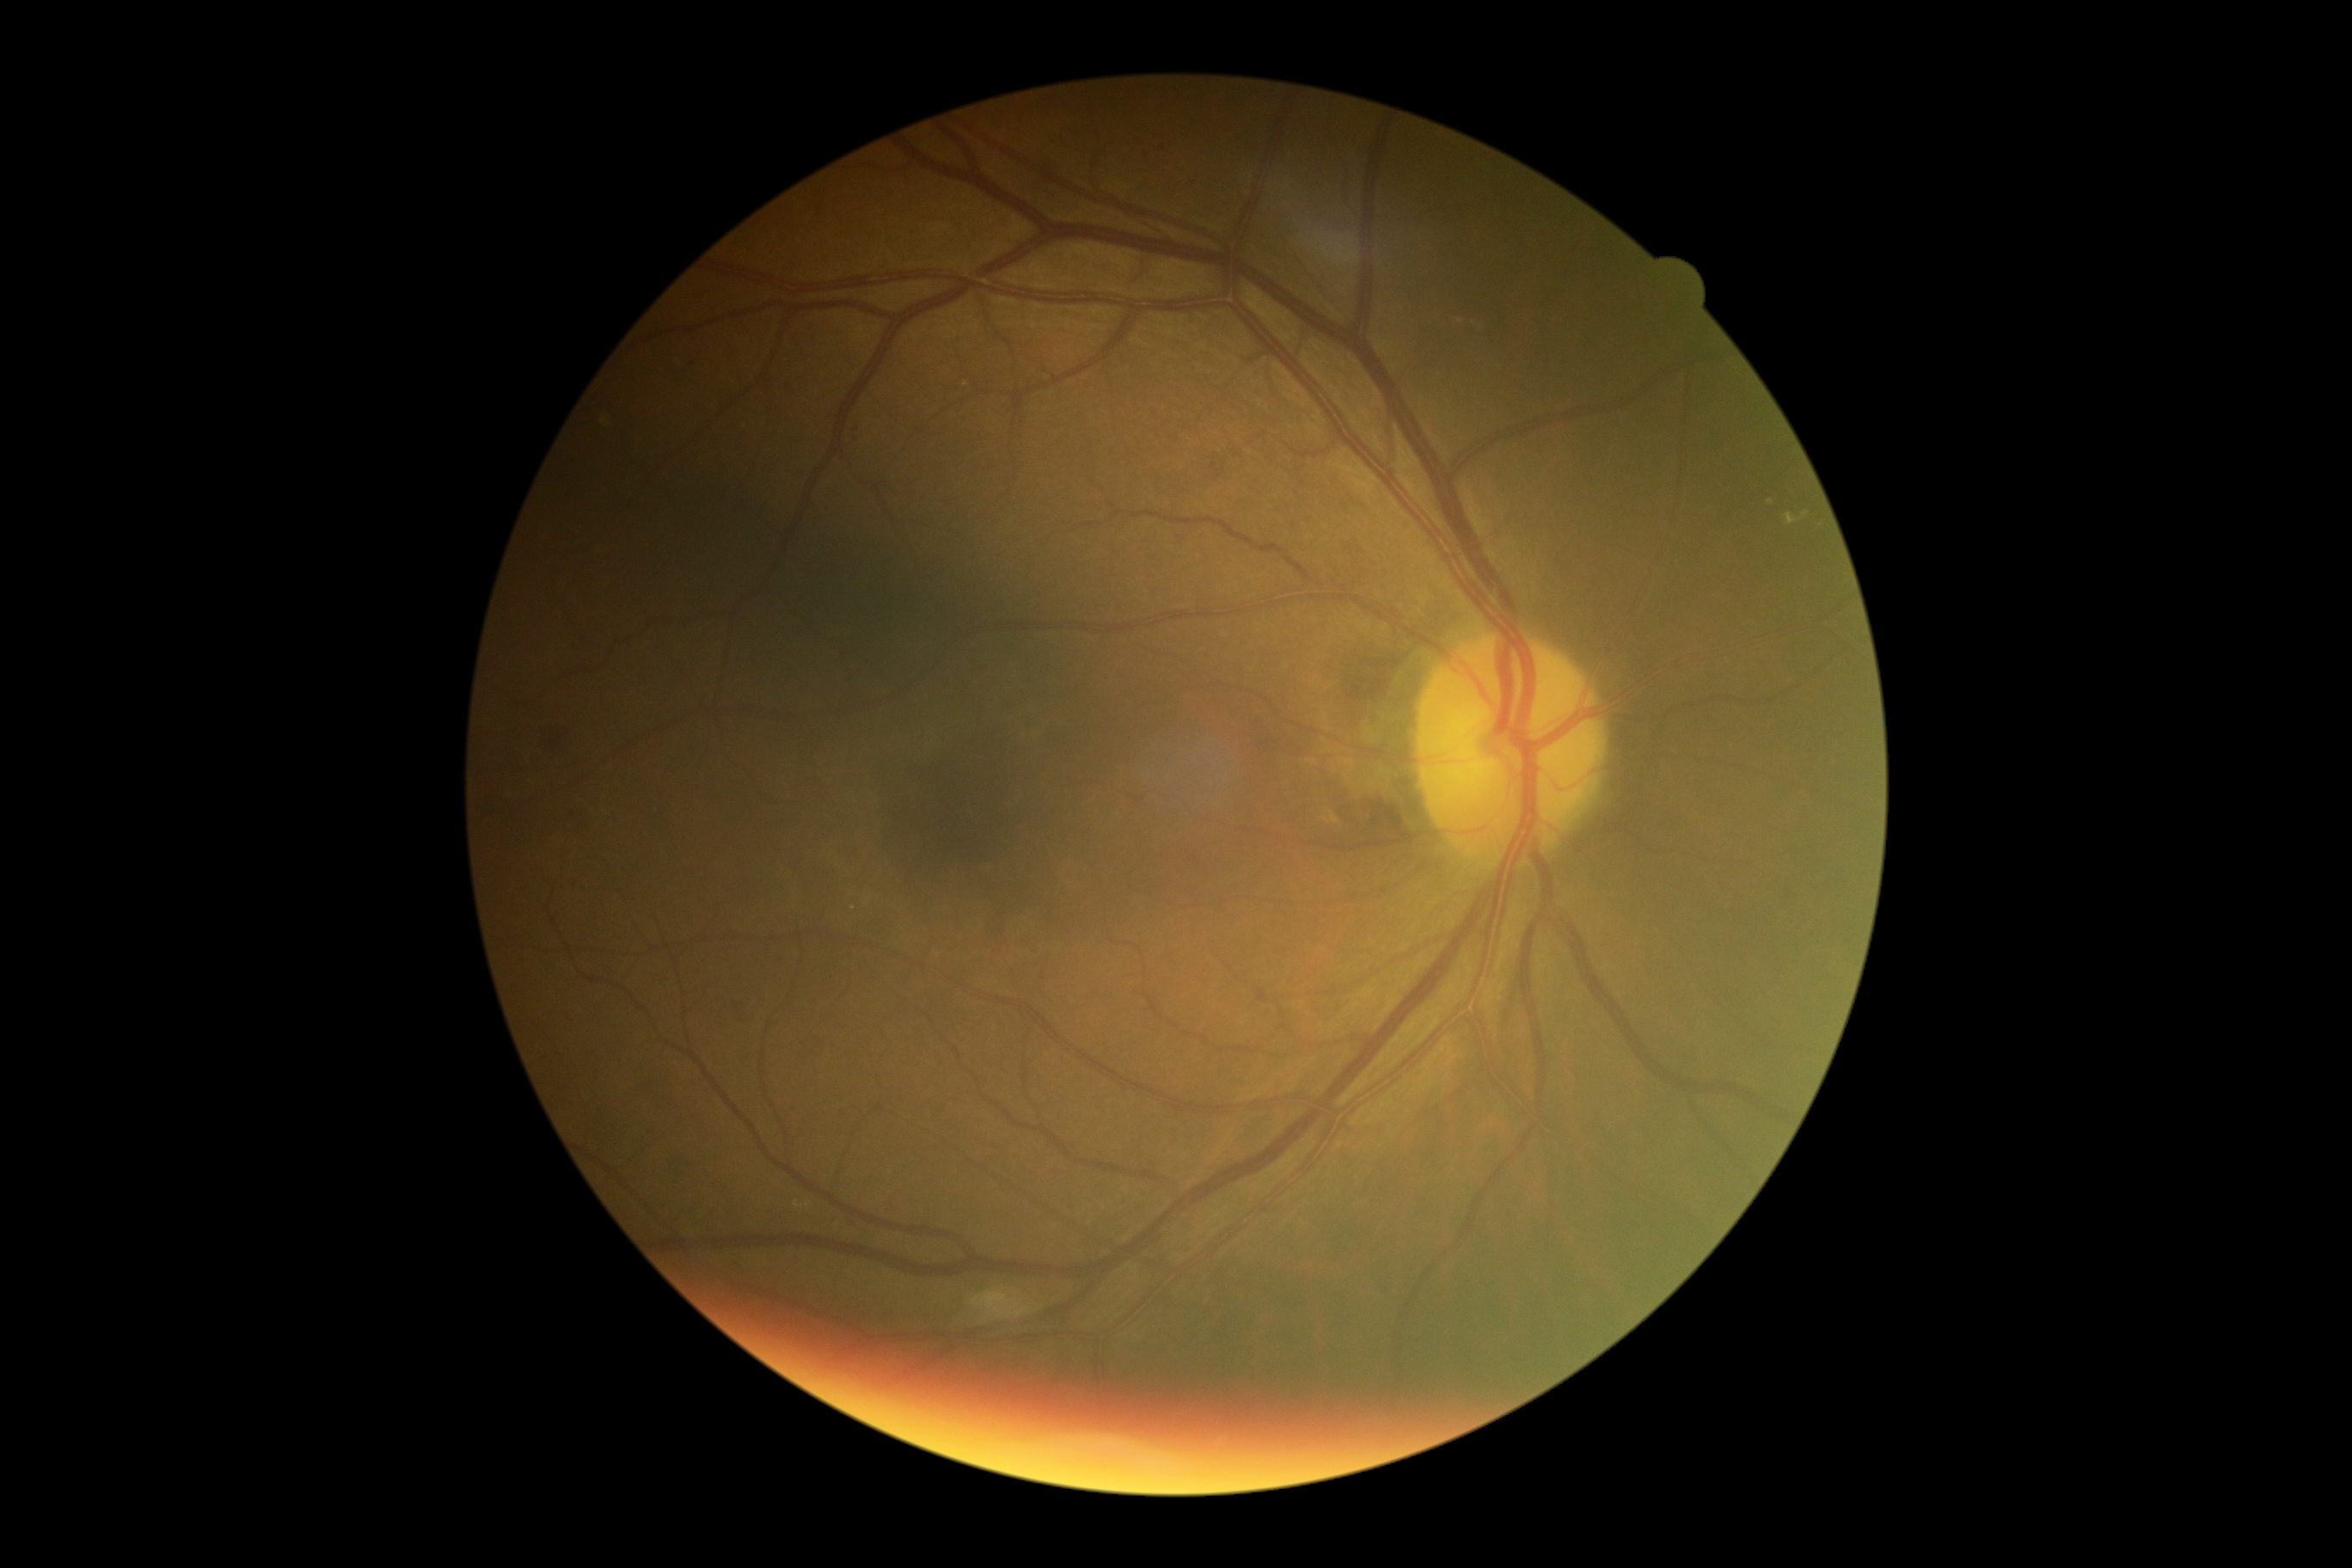 Diabetic retinopathy is moderate NPDR (grade 2).